45° FOV
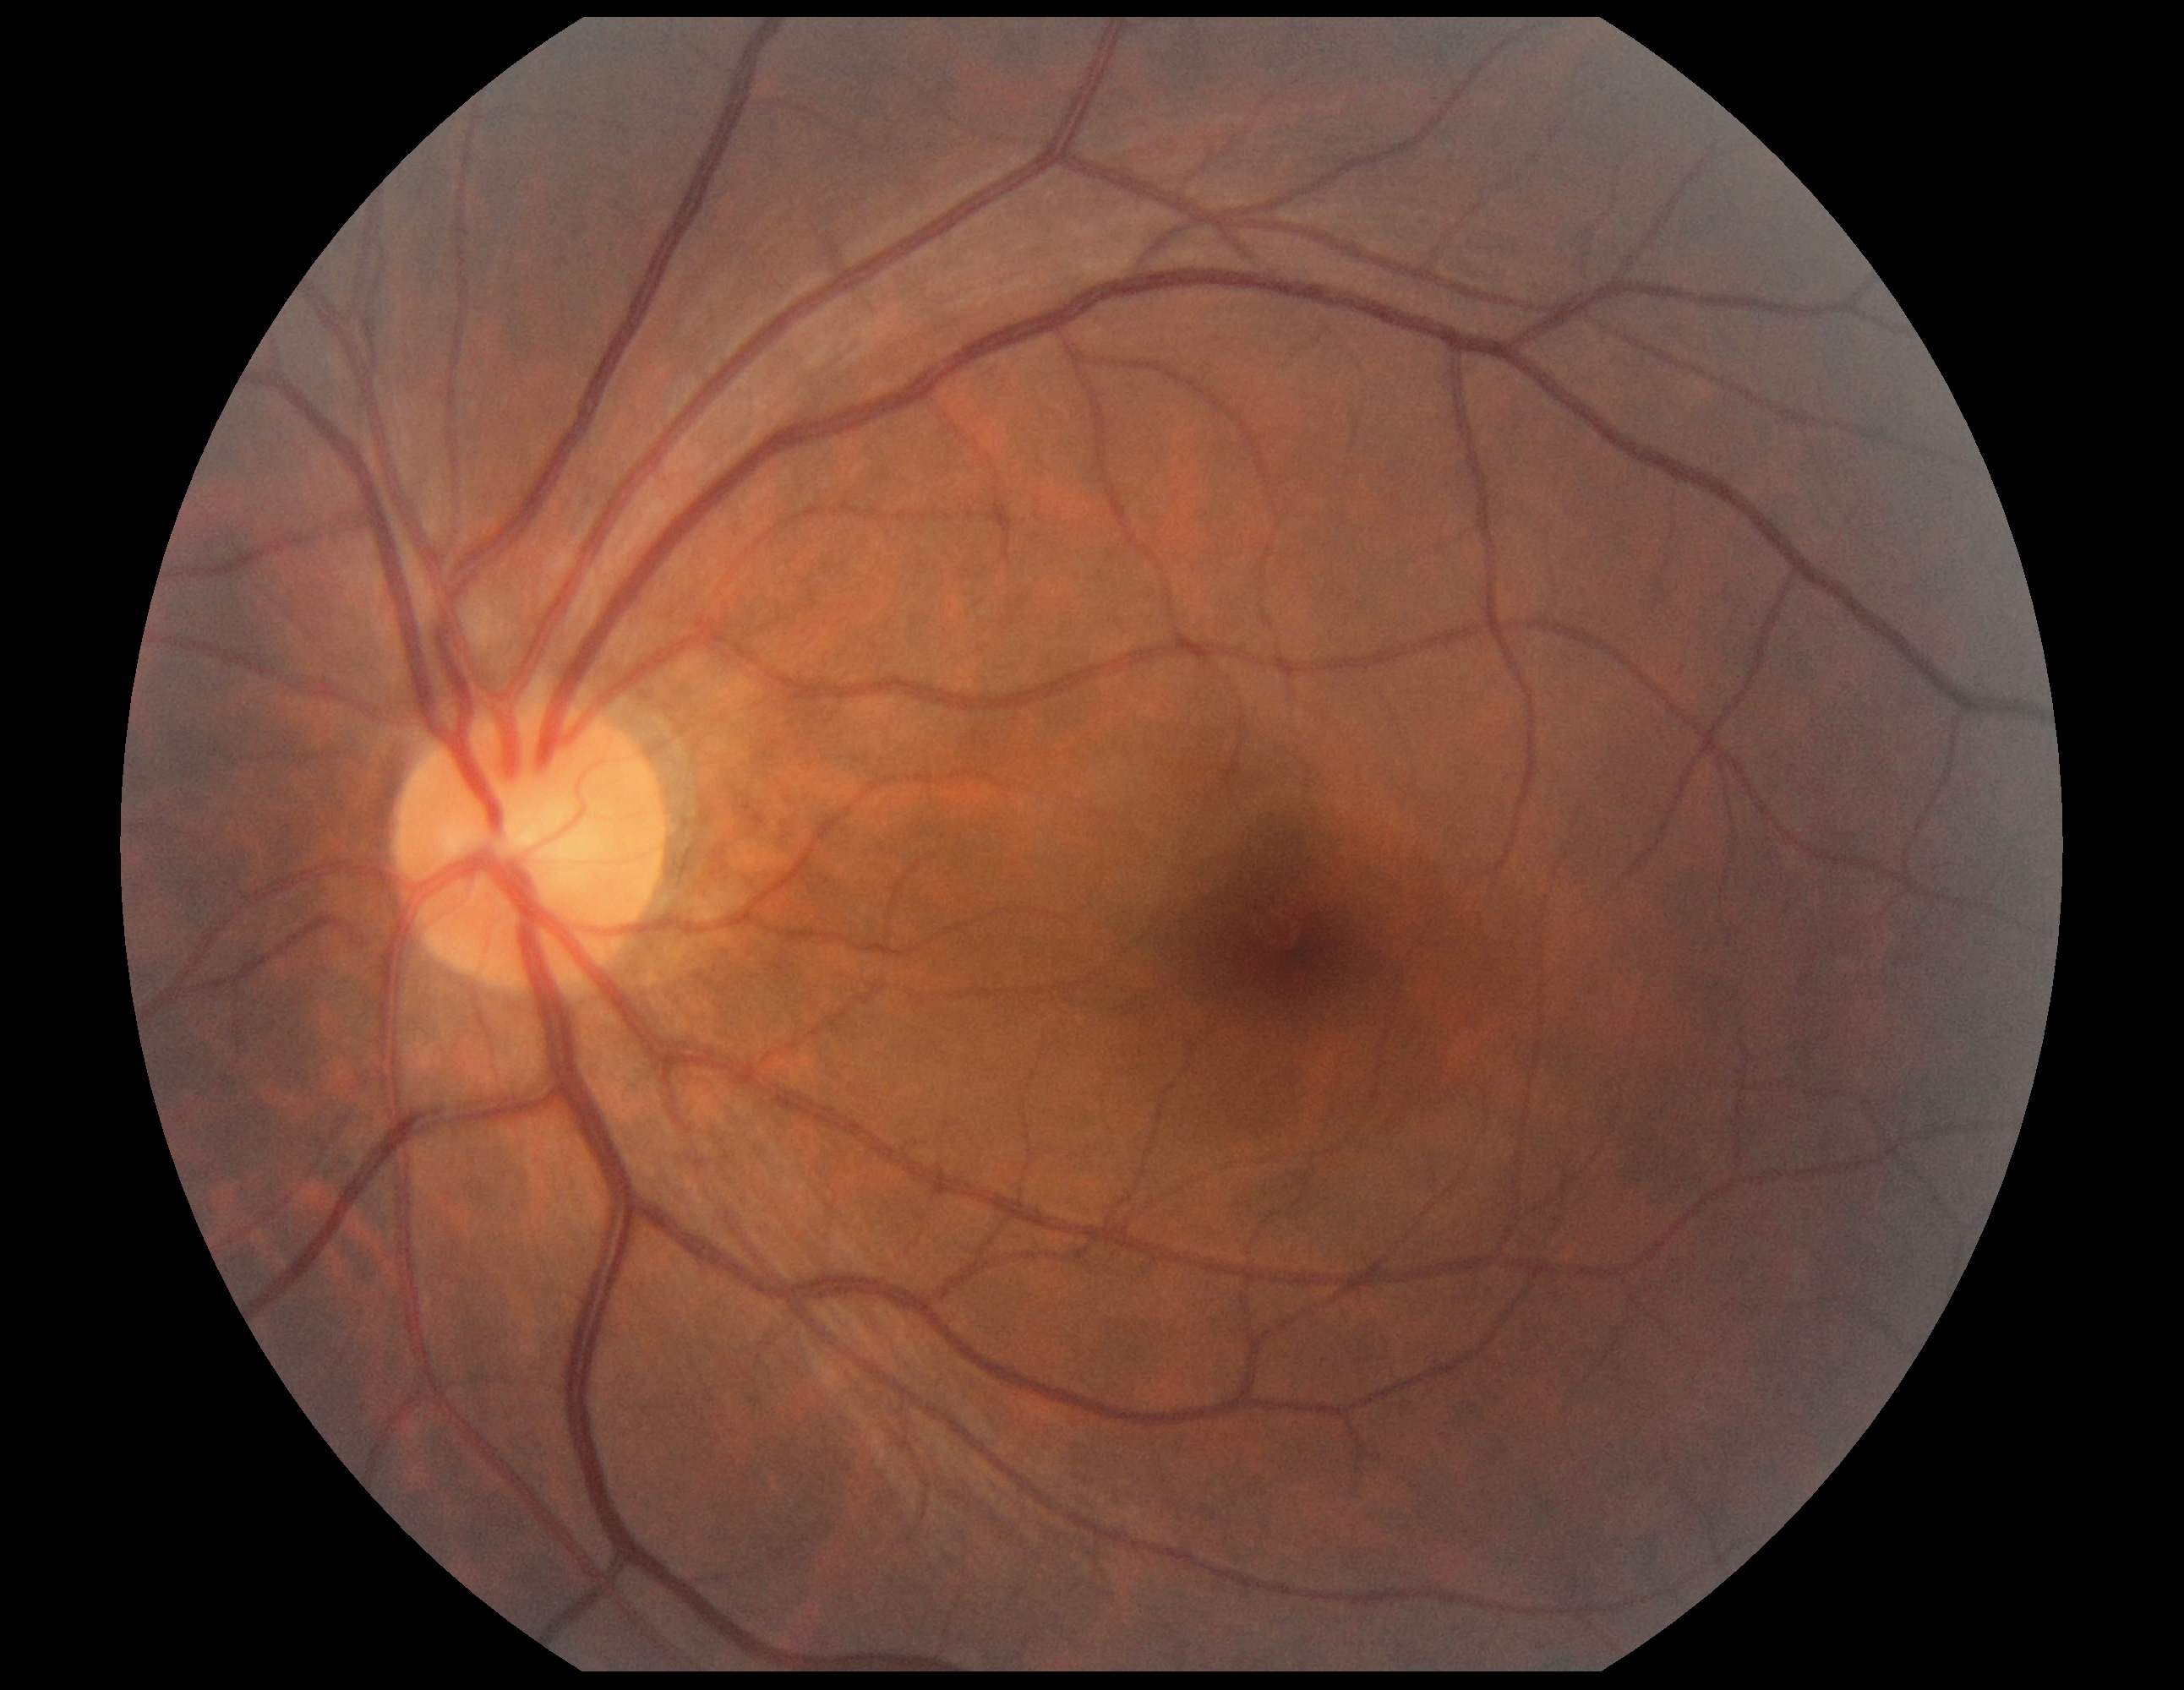

Diabetic retinopathy: no apparent retinopathy (grade 0).